45° FOV, 2352 x 1568 pixels
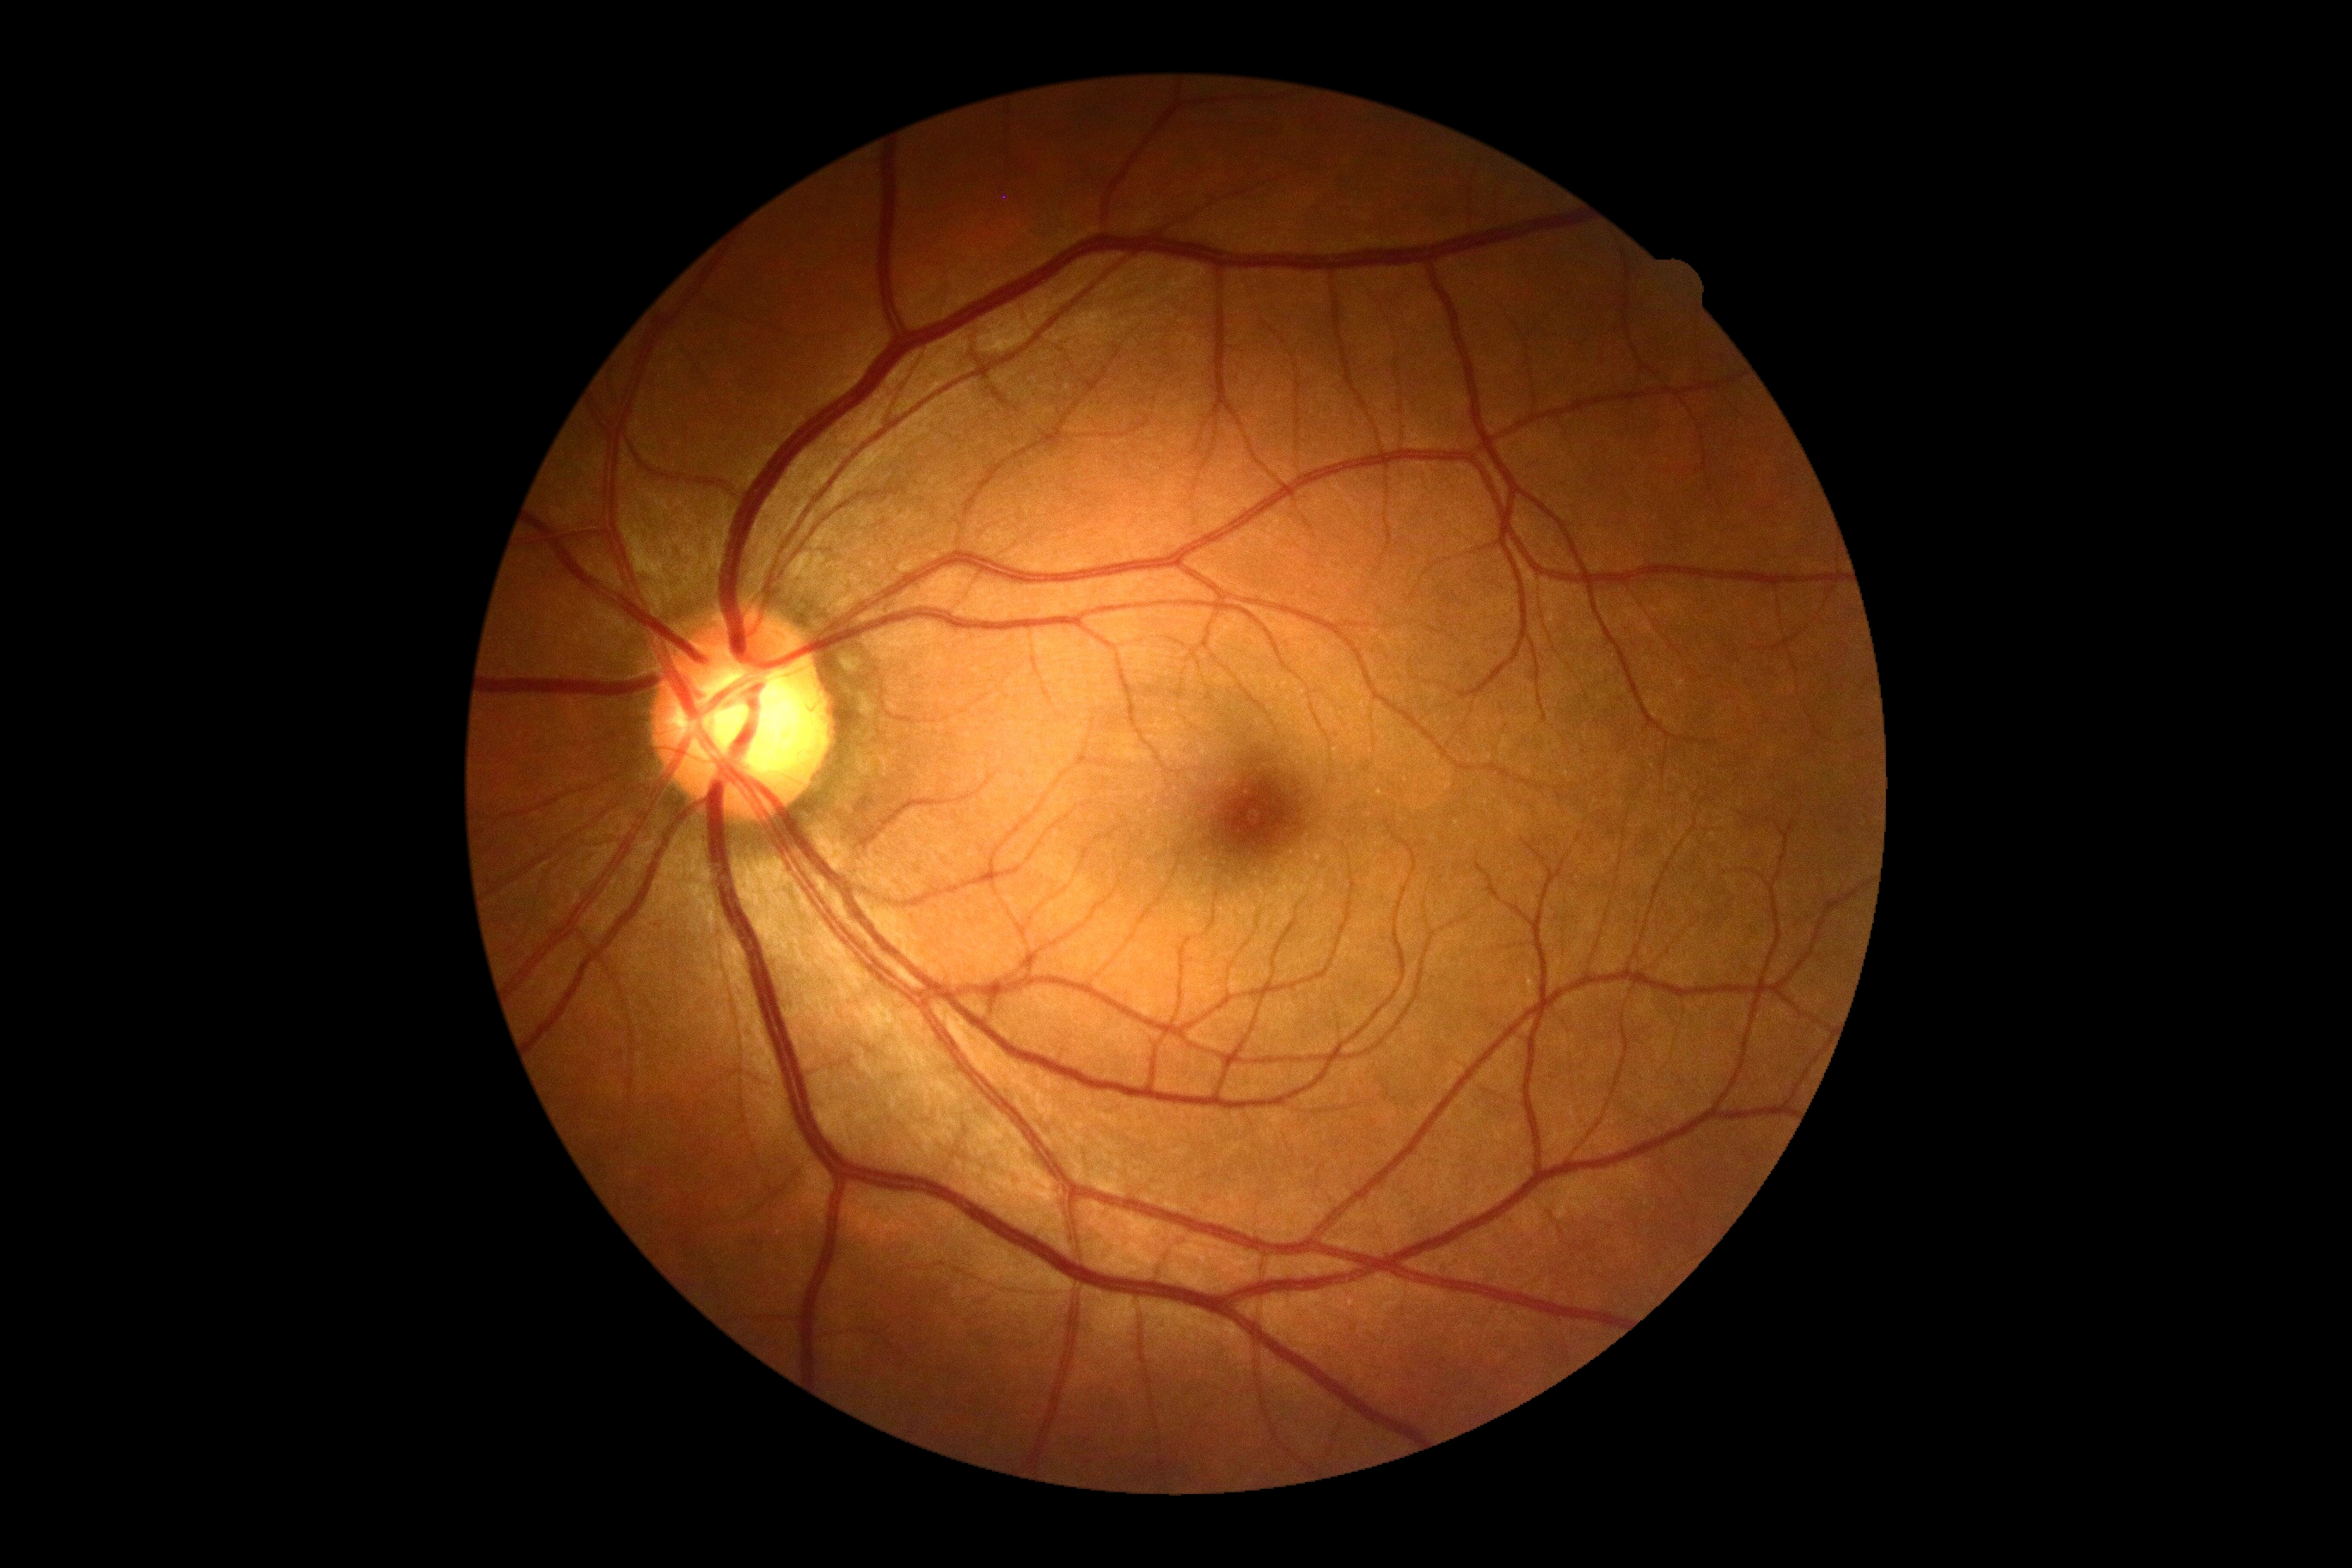

diabetic retinopathy severity: grade 0 (no apparent retinopathy).